640 x 480 pixels; pediatric wide-field fundus photograph: 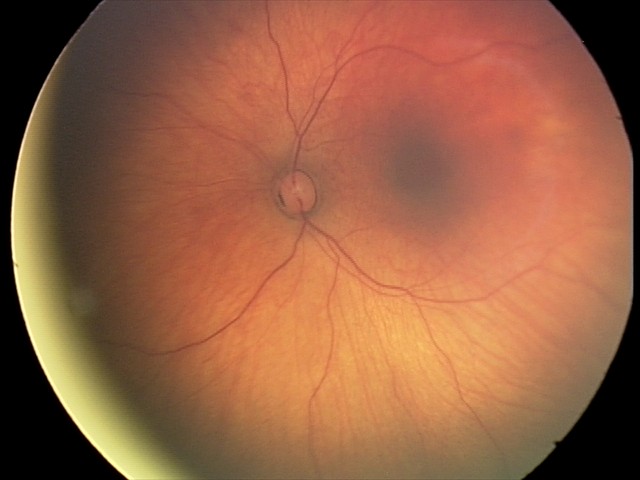 Screening examination consistent with retinal hemorrhages.